1936x1296px · color fundus image:
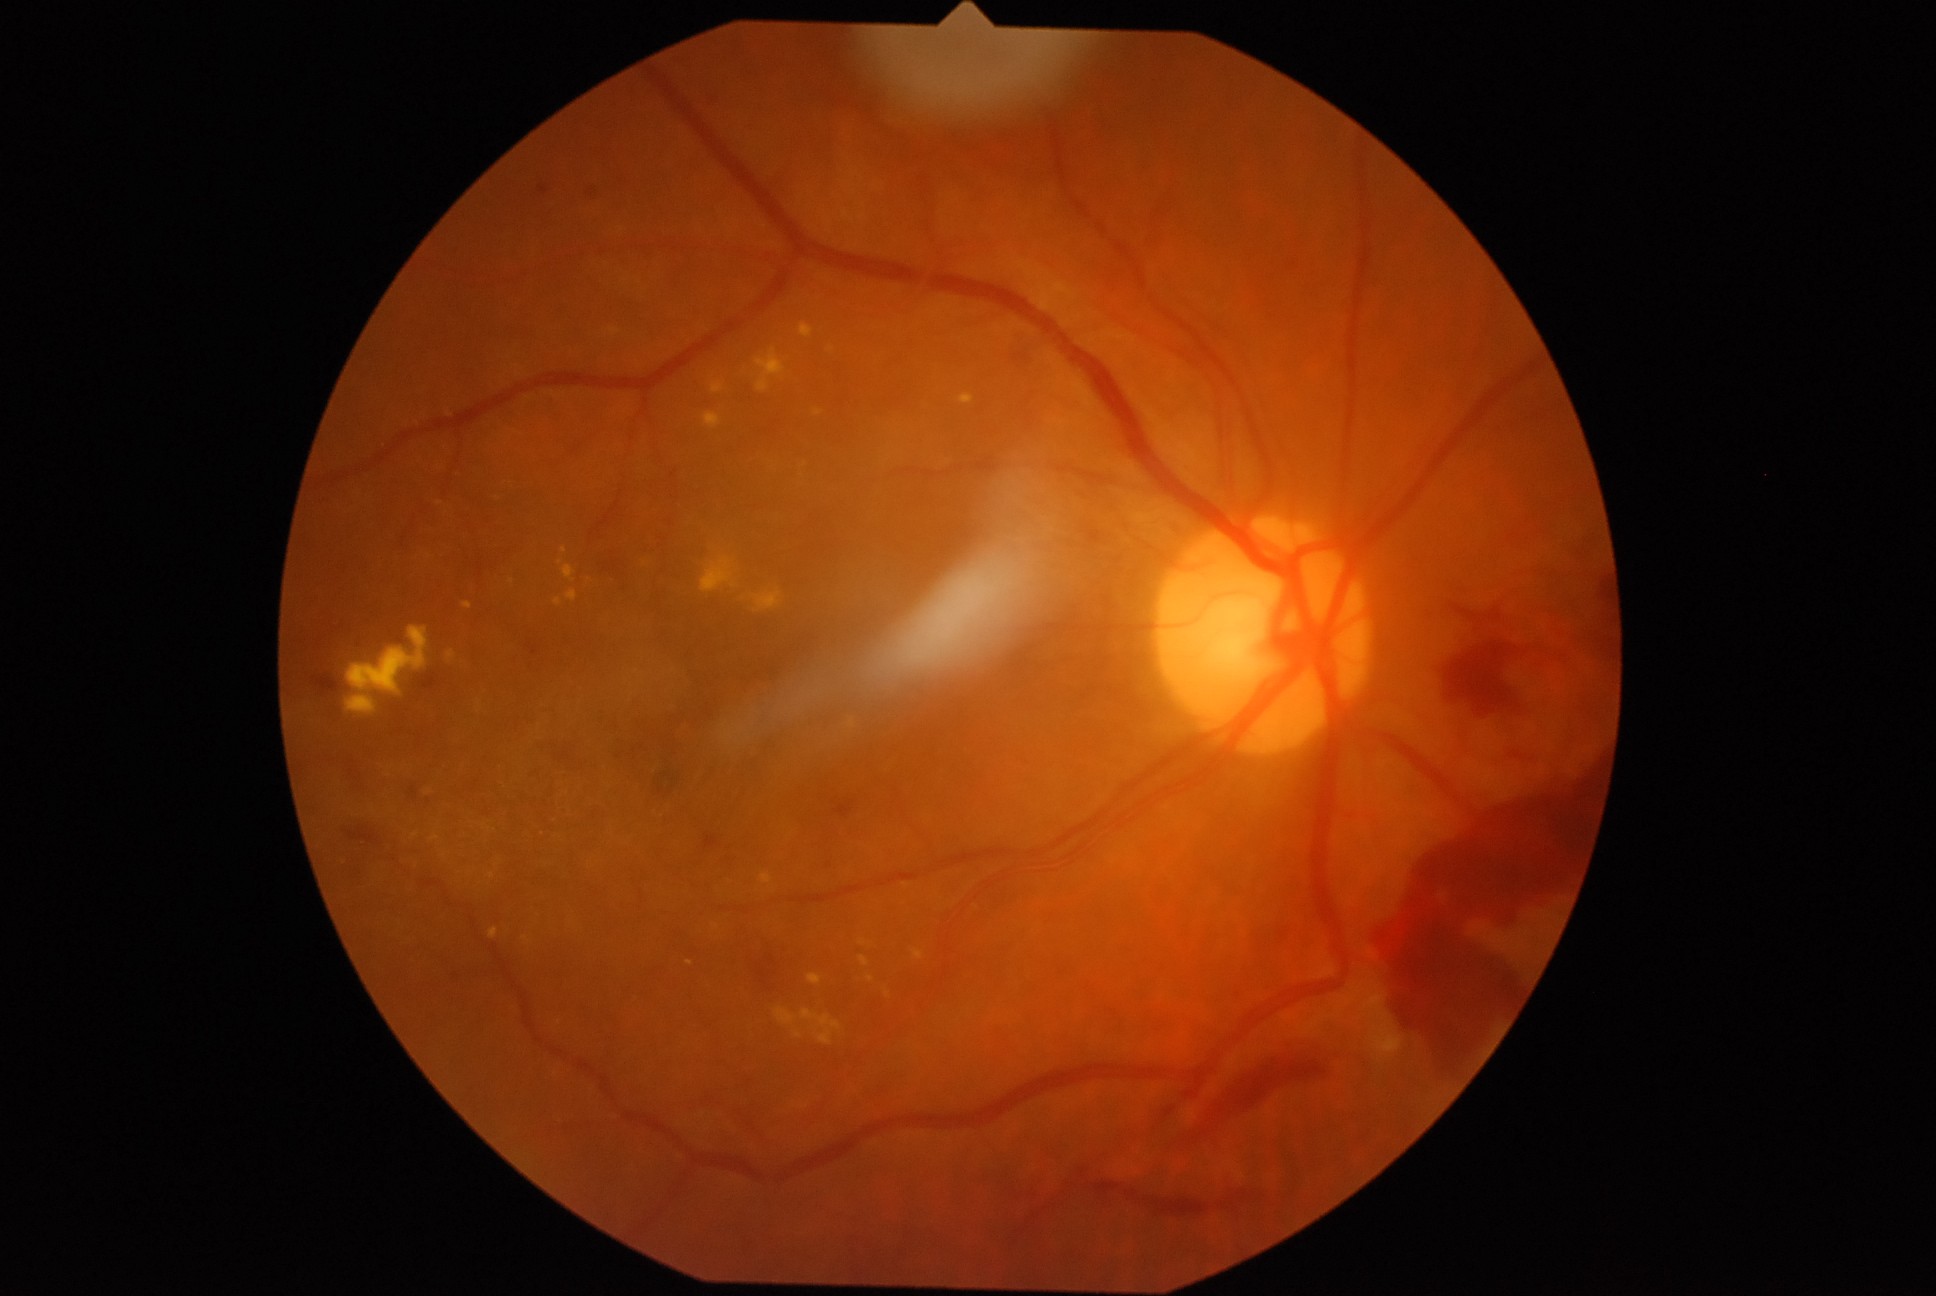
DR grade: 4 (PDR) — neovascularization and/or vitreous/pre-retinal hemorrhage
Representative lesions:
HEs (subset): (835,807,853,817); (1457,590,1517,629); (446,969,460,982); (1160,1200,1212,1216); (821,859,831,870); (767,669,778,677); (1596,578,1612,598); (1179,1050,1335,1149); (347,828,380,845); (1015,347,1030,370); (550,746,575,770); (1219,1183,1254,1210)
Additional small HEs near point(619, 757)
EXs (subset): (711,382,725,394); (801,1009,842,1046); (554,599,562,607); (346,696,376,713); (859,957,869,967); (489,928,499,940); (431,837,439,841); (814,410,823,416); (800,323,814,339); (756,348,786,393); (704,412,722,430); (522,937,531,944); (462,602,472,610); (567,590,577,603)
Additional small EXs near point(561, 563); point(805, 466); point(564, 550); point(512, 582); point(415, 836); point(871, 979)